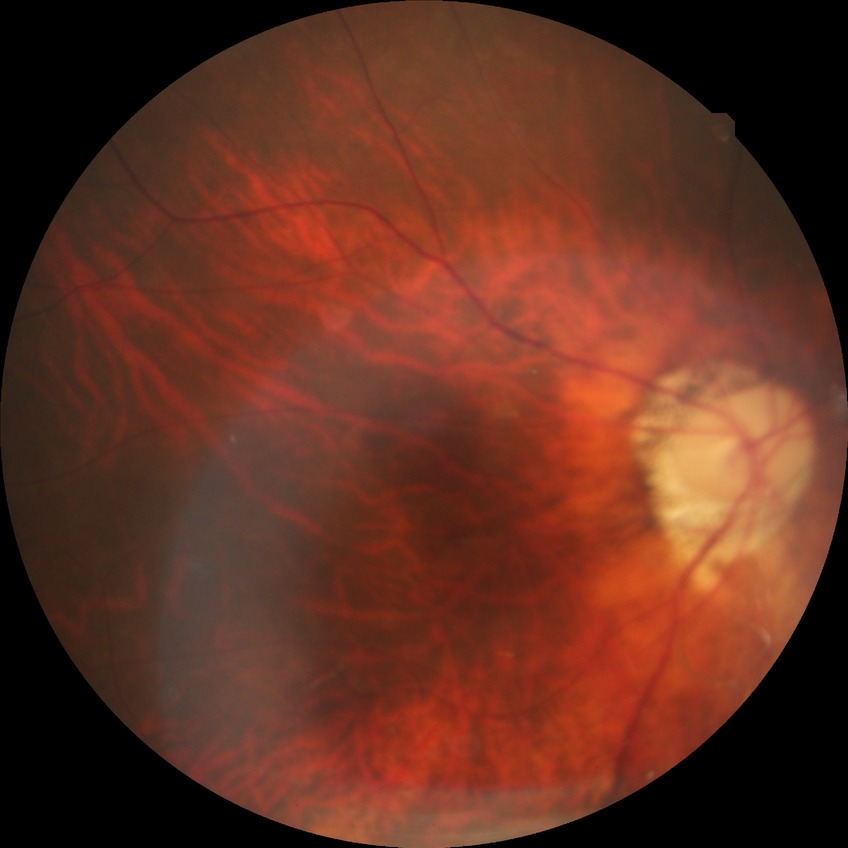

diabetic retinopathy (DR)=no diabetic retinopathy (NDR).